Modified Davis grading:
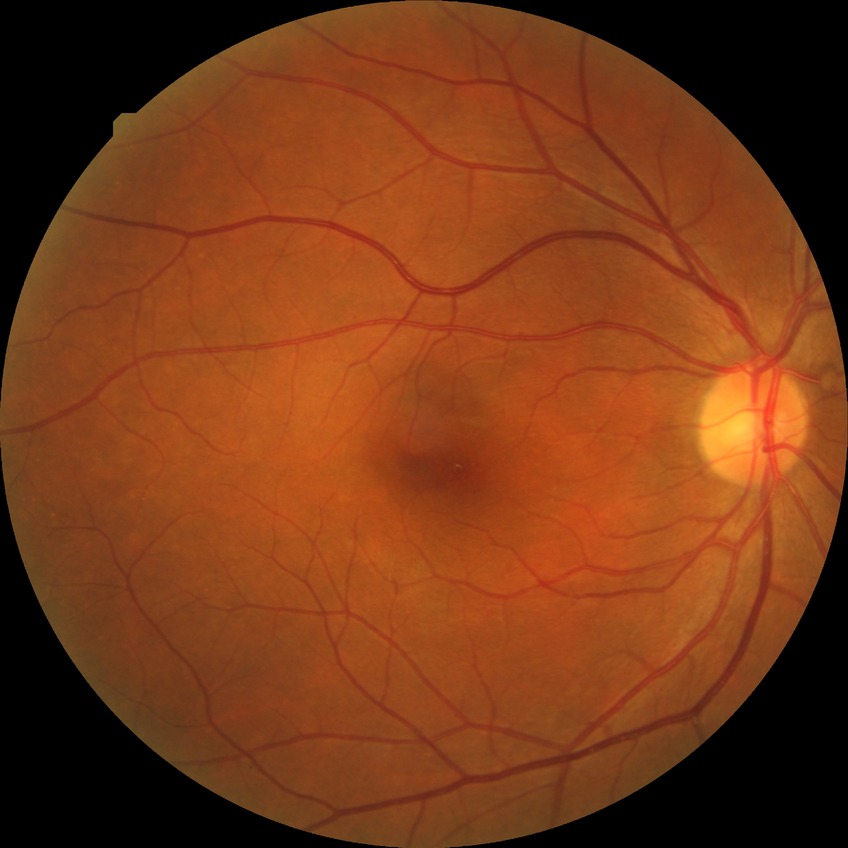
Modified Davis grading is no diabetic retinopathy.